45° FOV
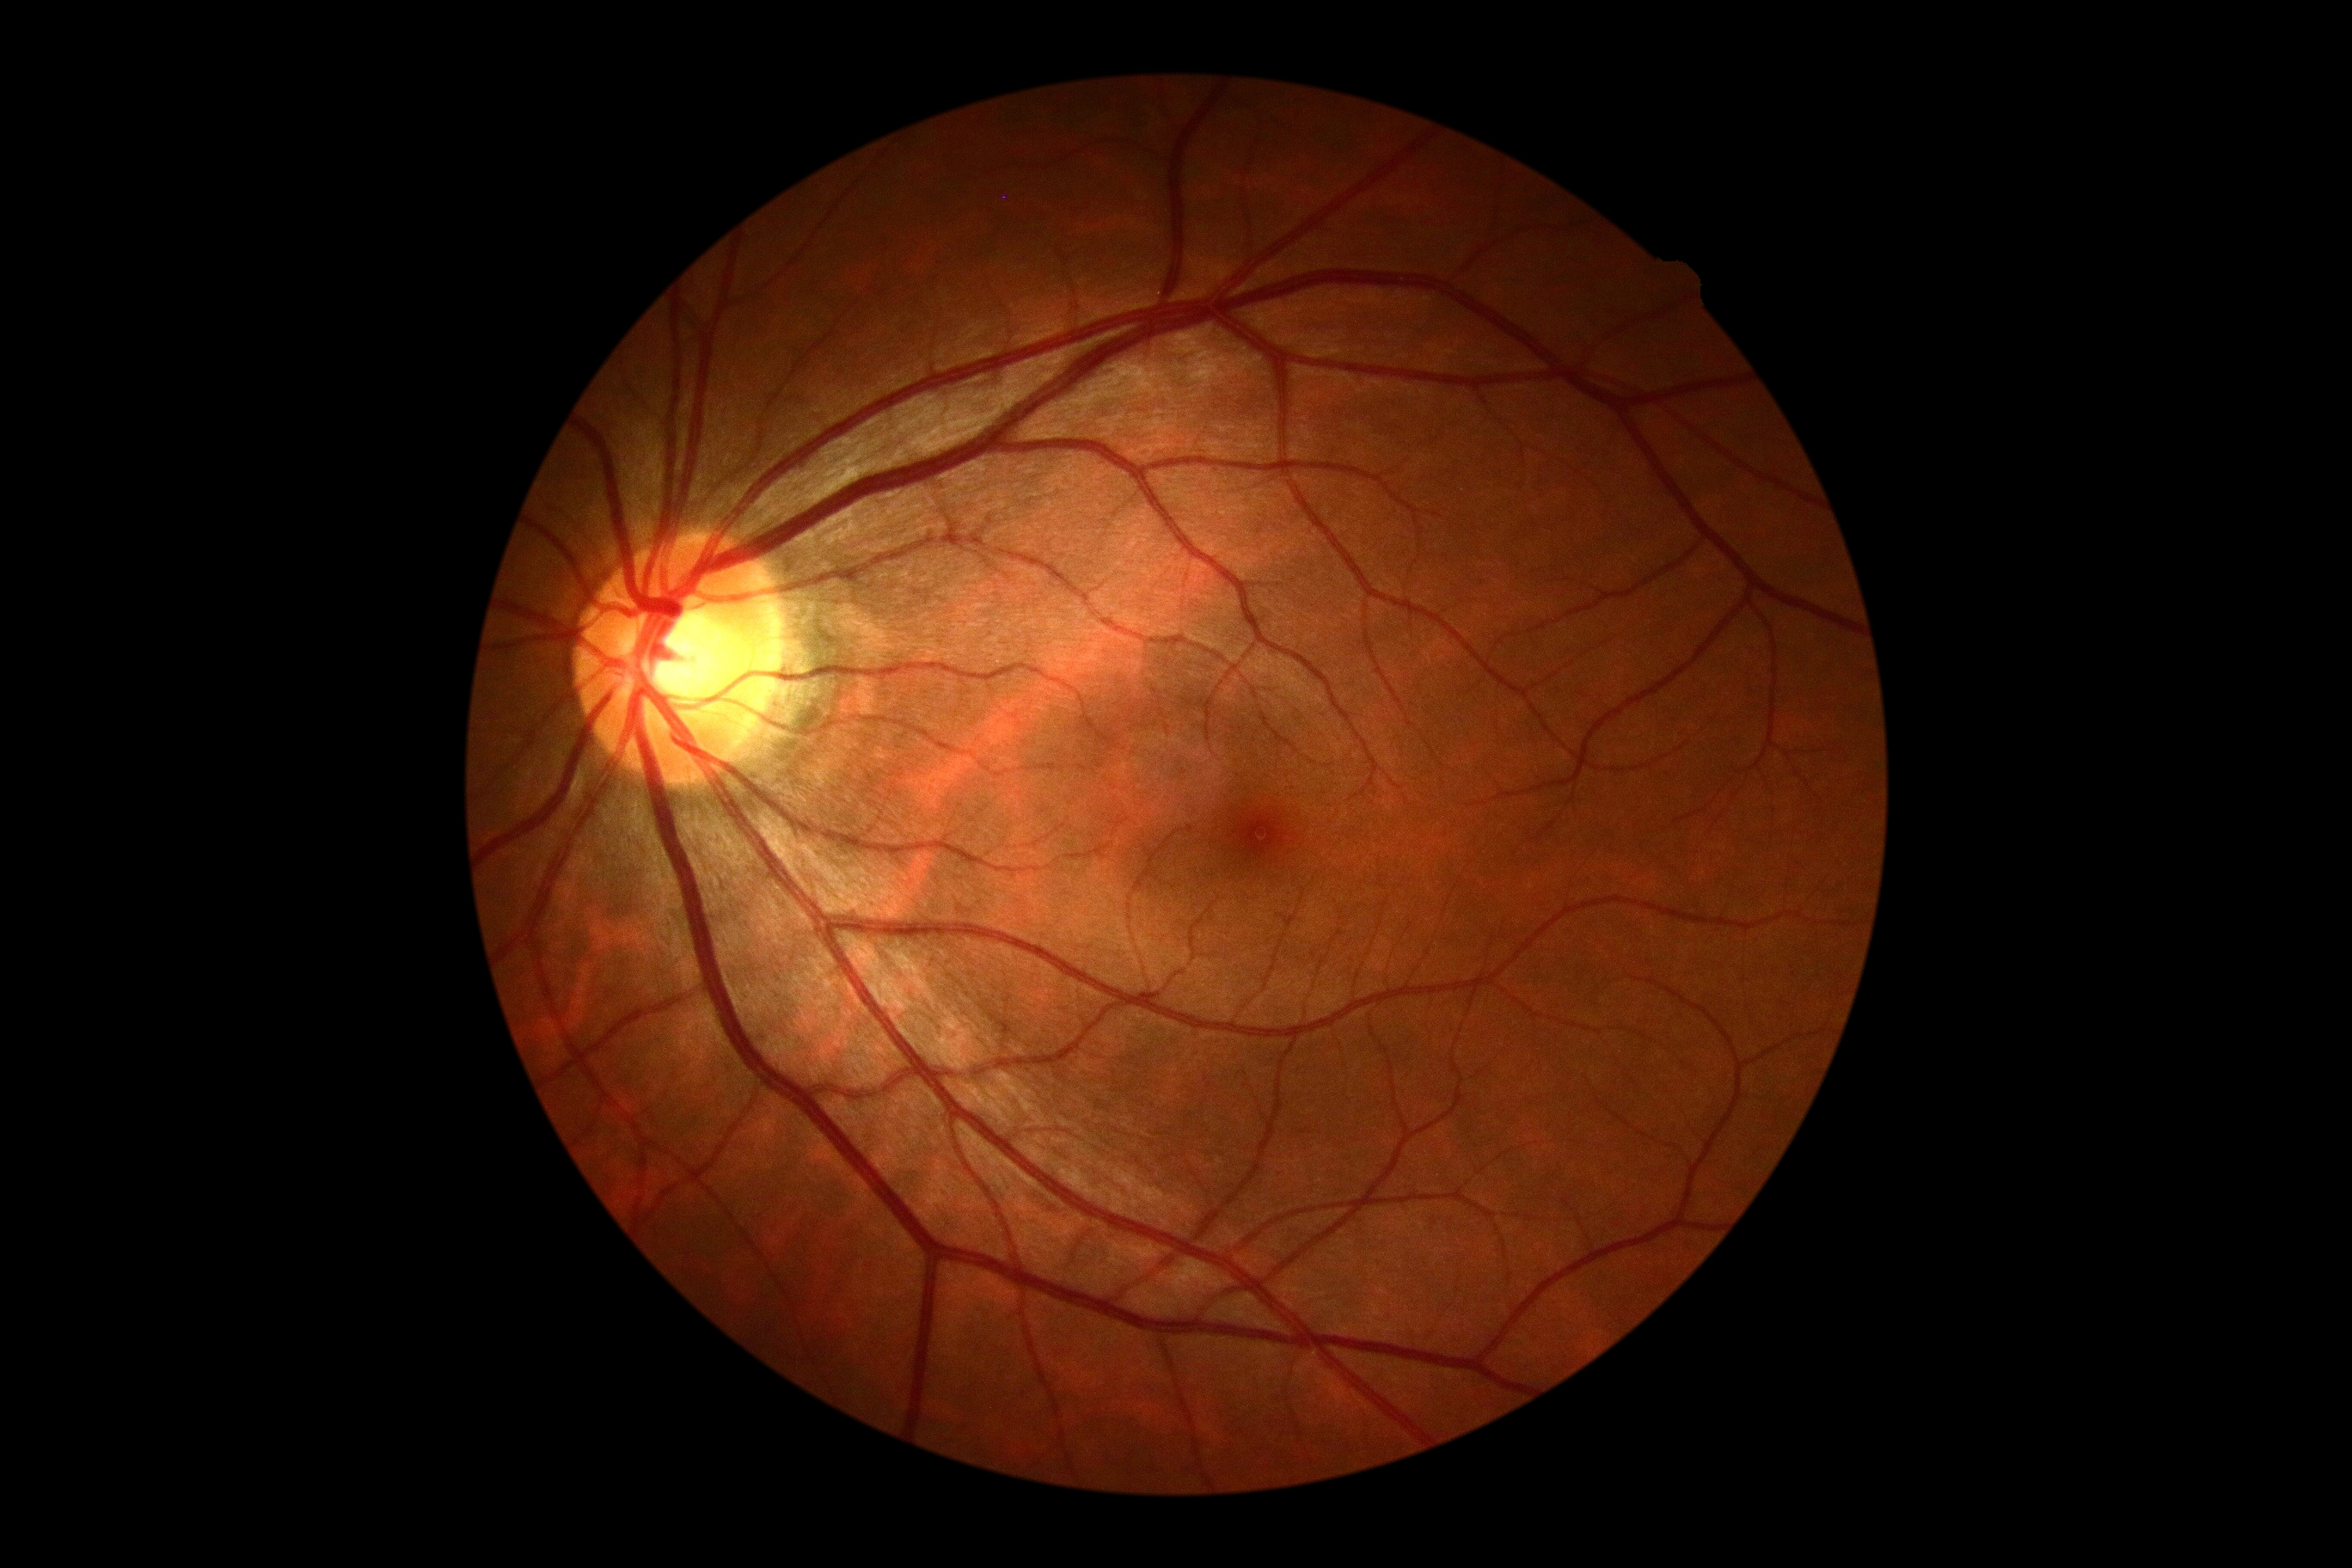 DR grade is 0/4 — no visible signs of diabetic retinopathy. No apparent diabetic retinopathy.